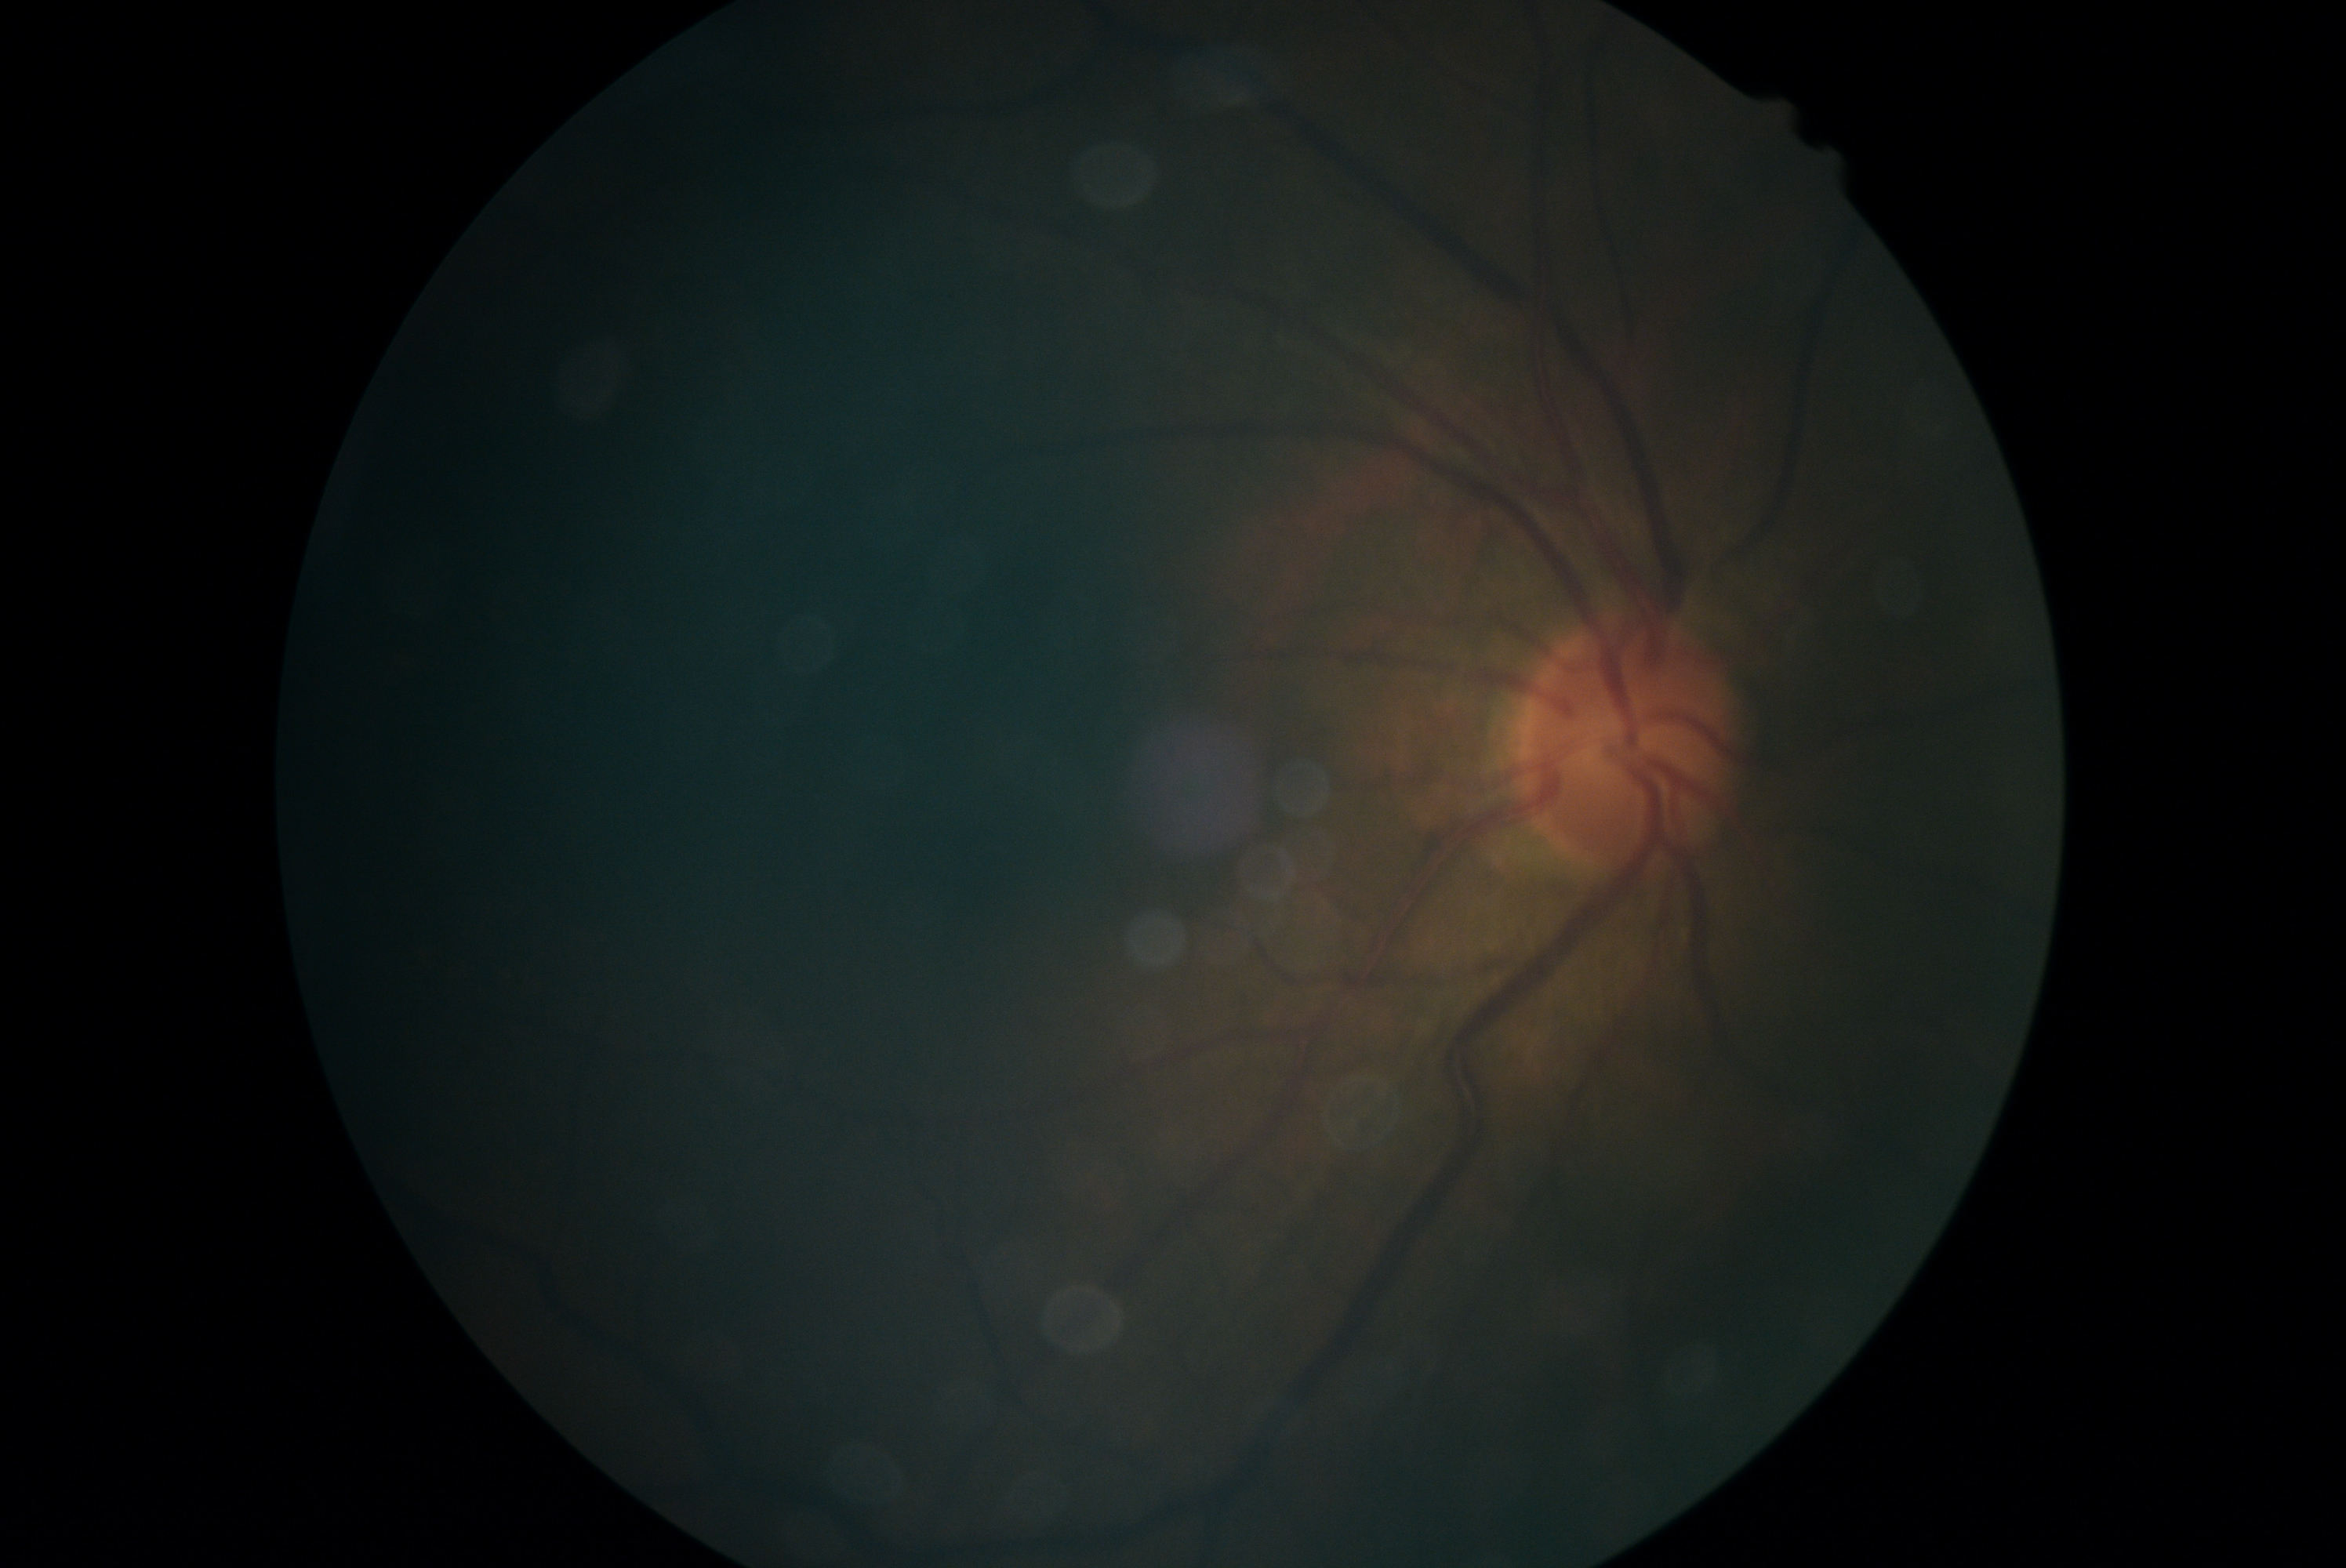
Diabetic retinopathy (DR): ungradable.